CFP: 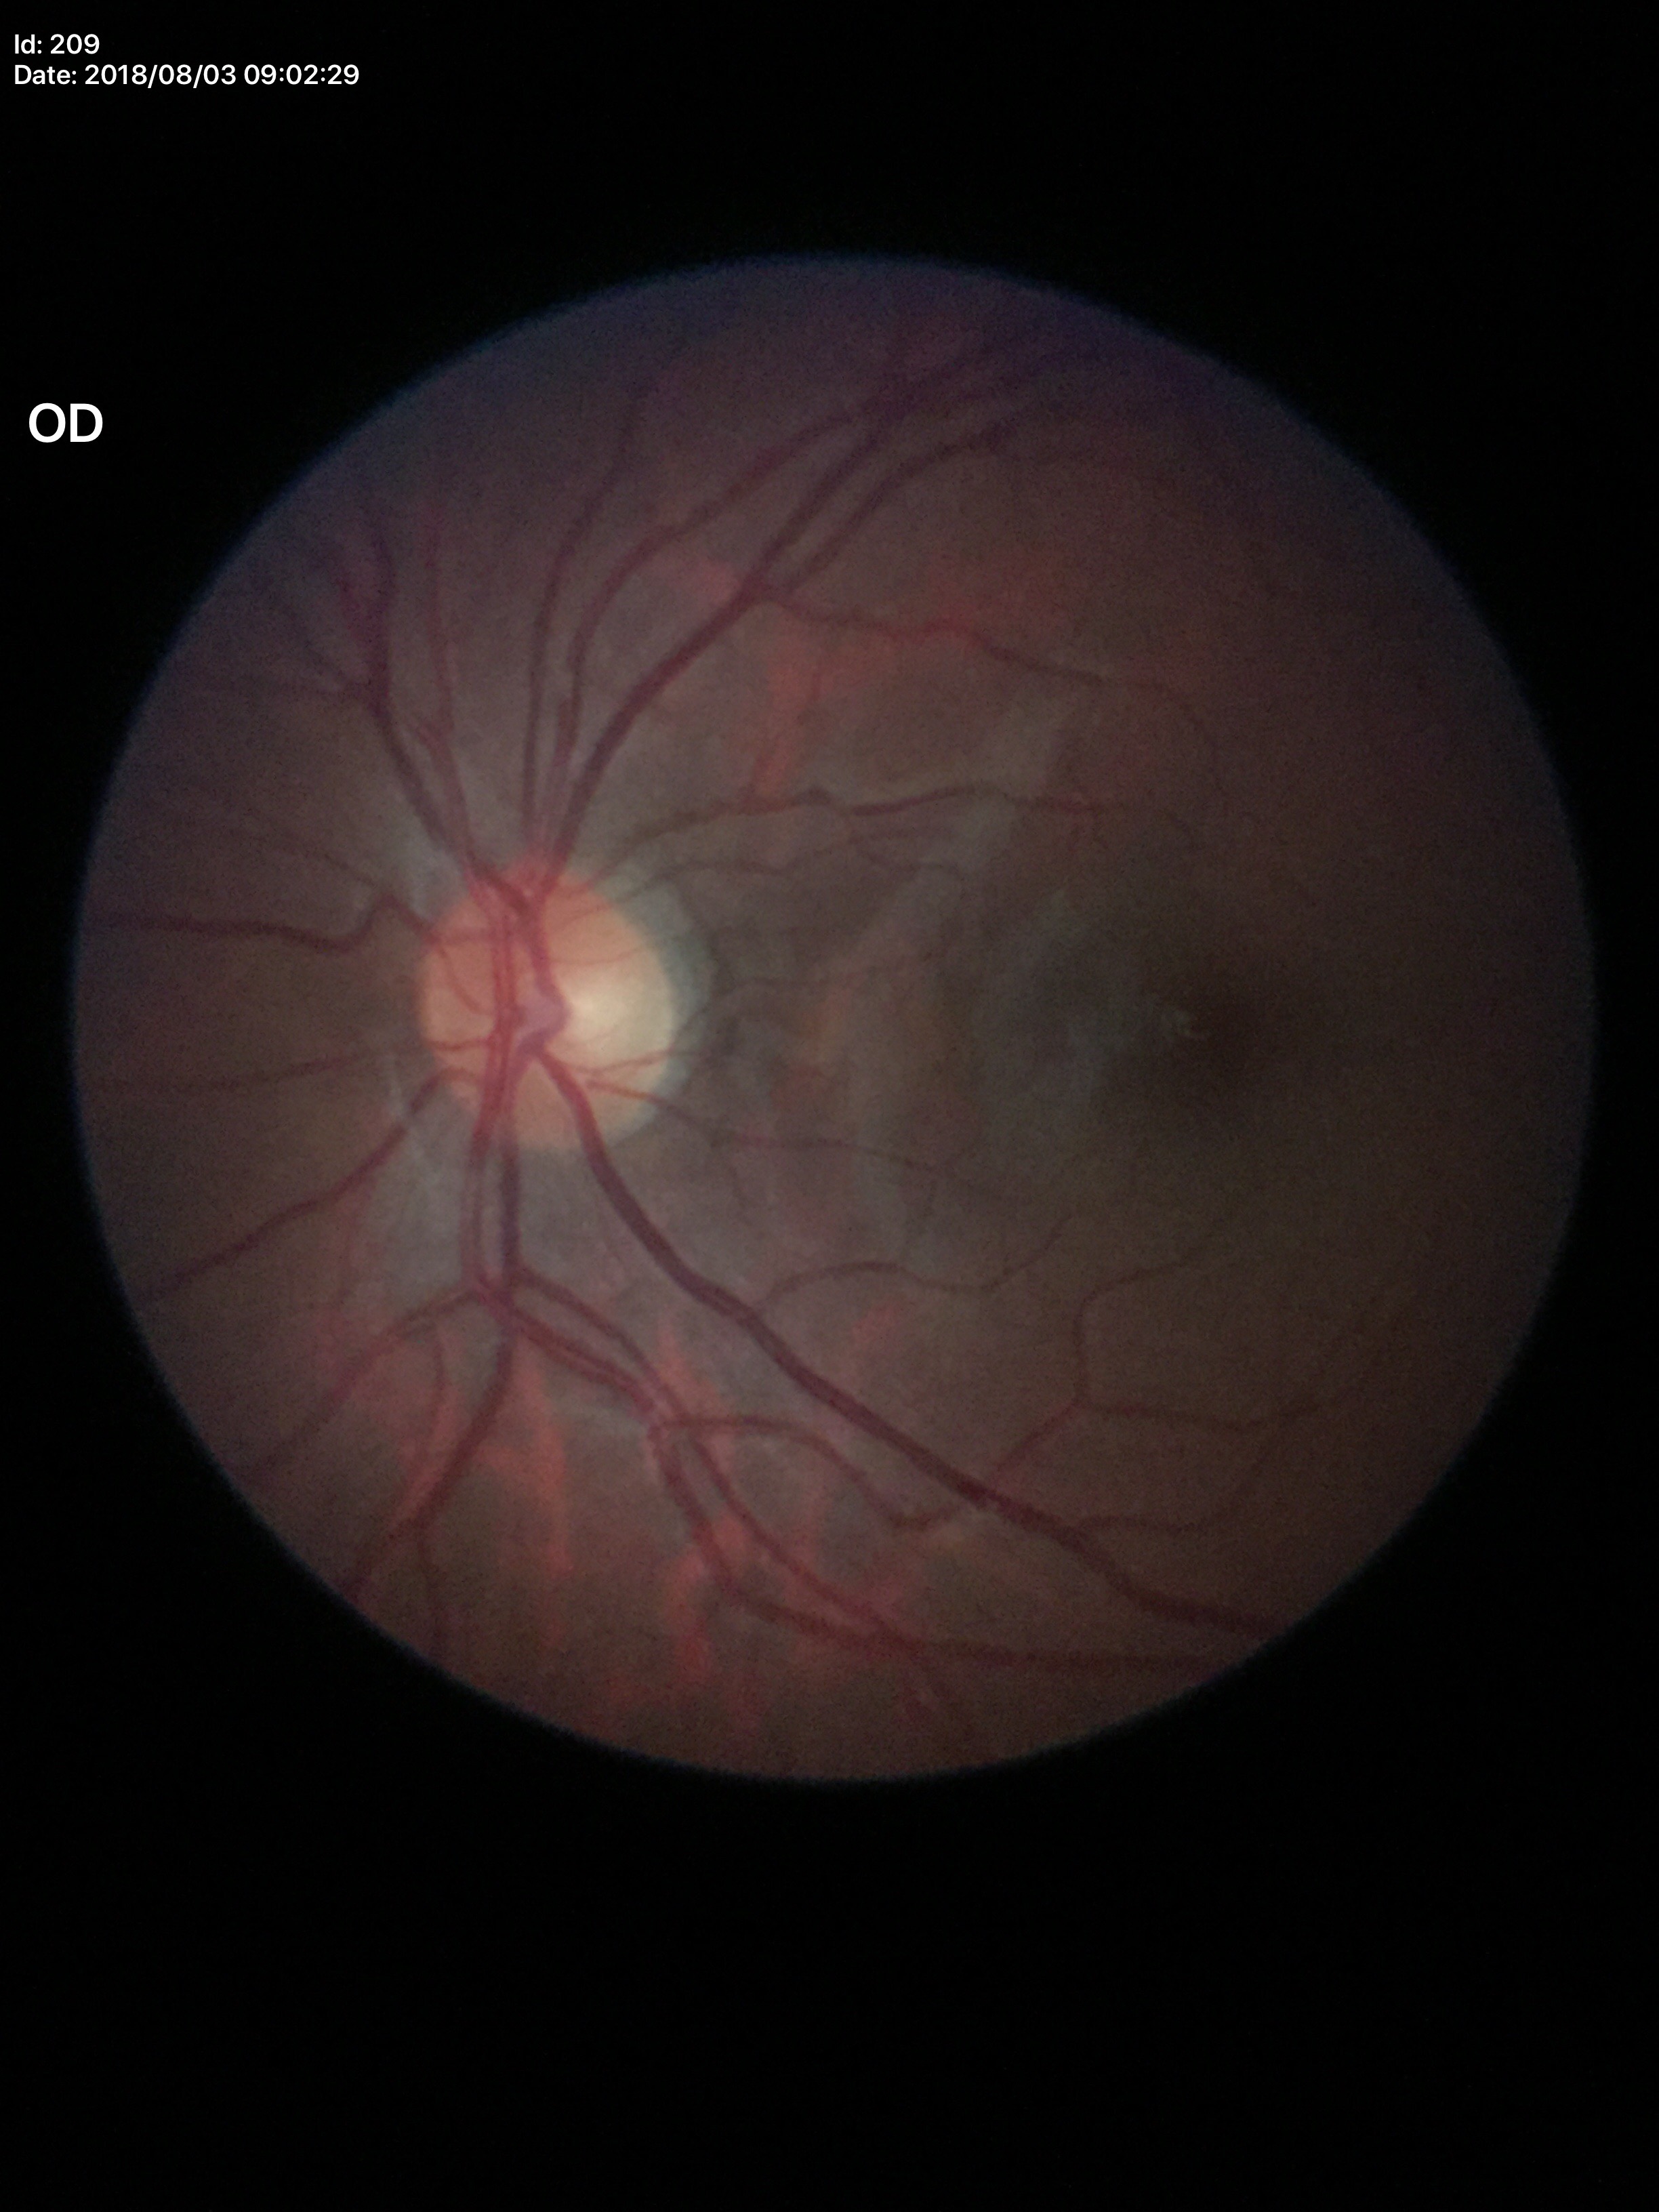 No signs of glaucoma (5/5 ophthalmologists in agreement).
Vertical CDR (VCDR): 0.40.